Retinal fundus photograph:
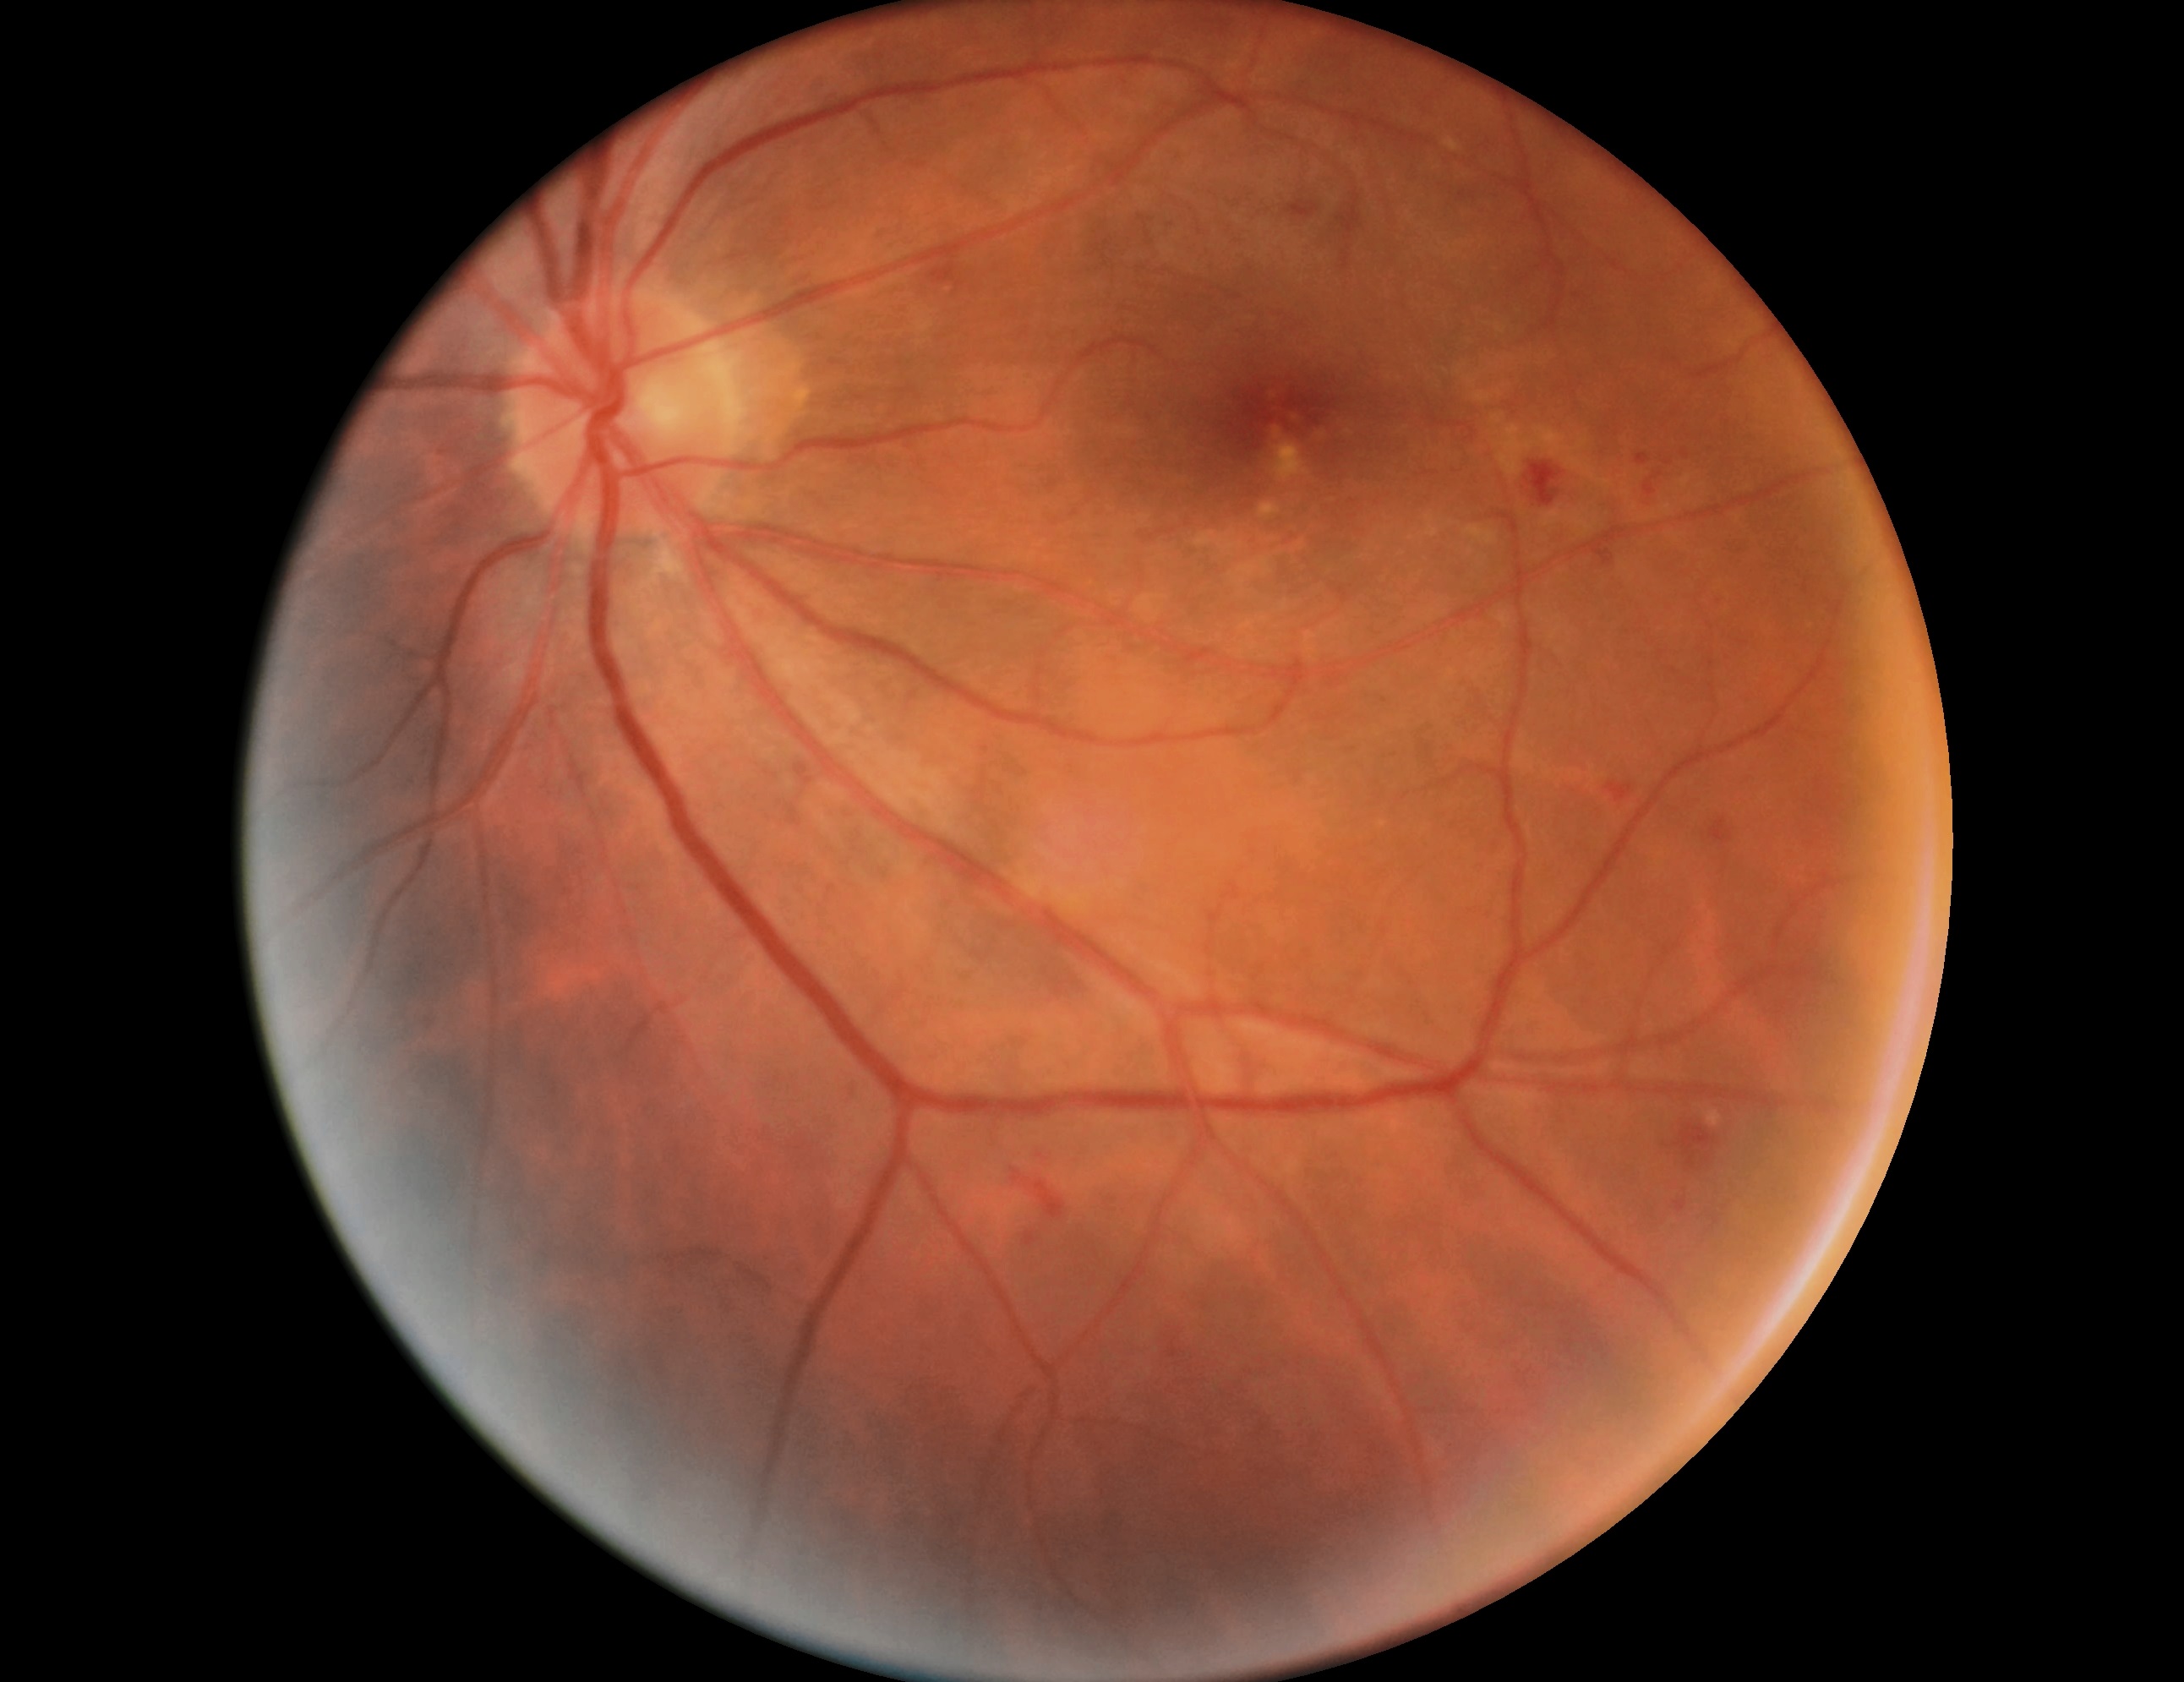 Diabetic retinopathy (DR): 2.